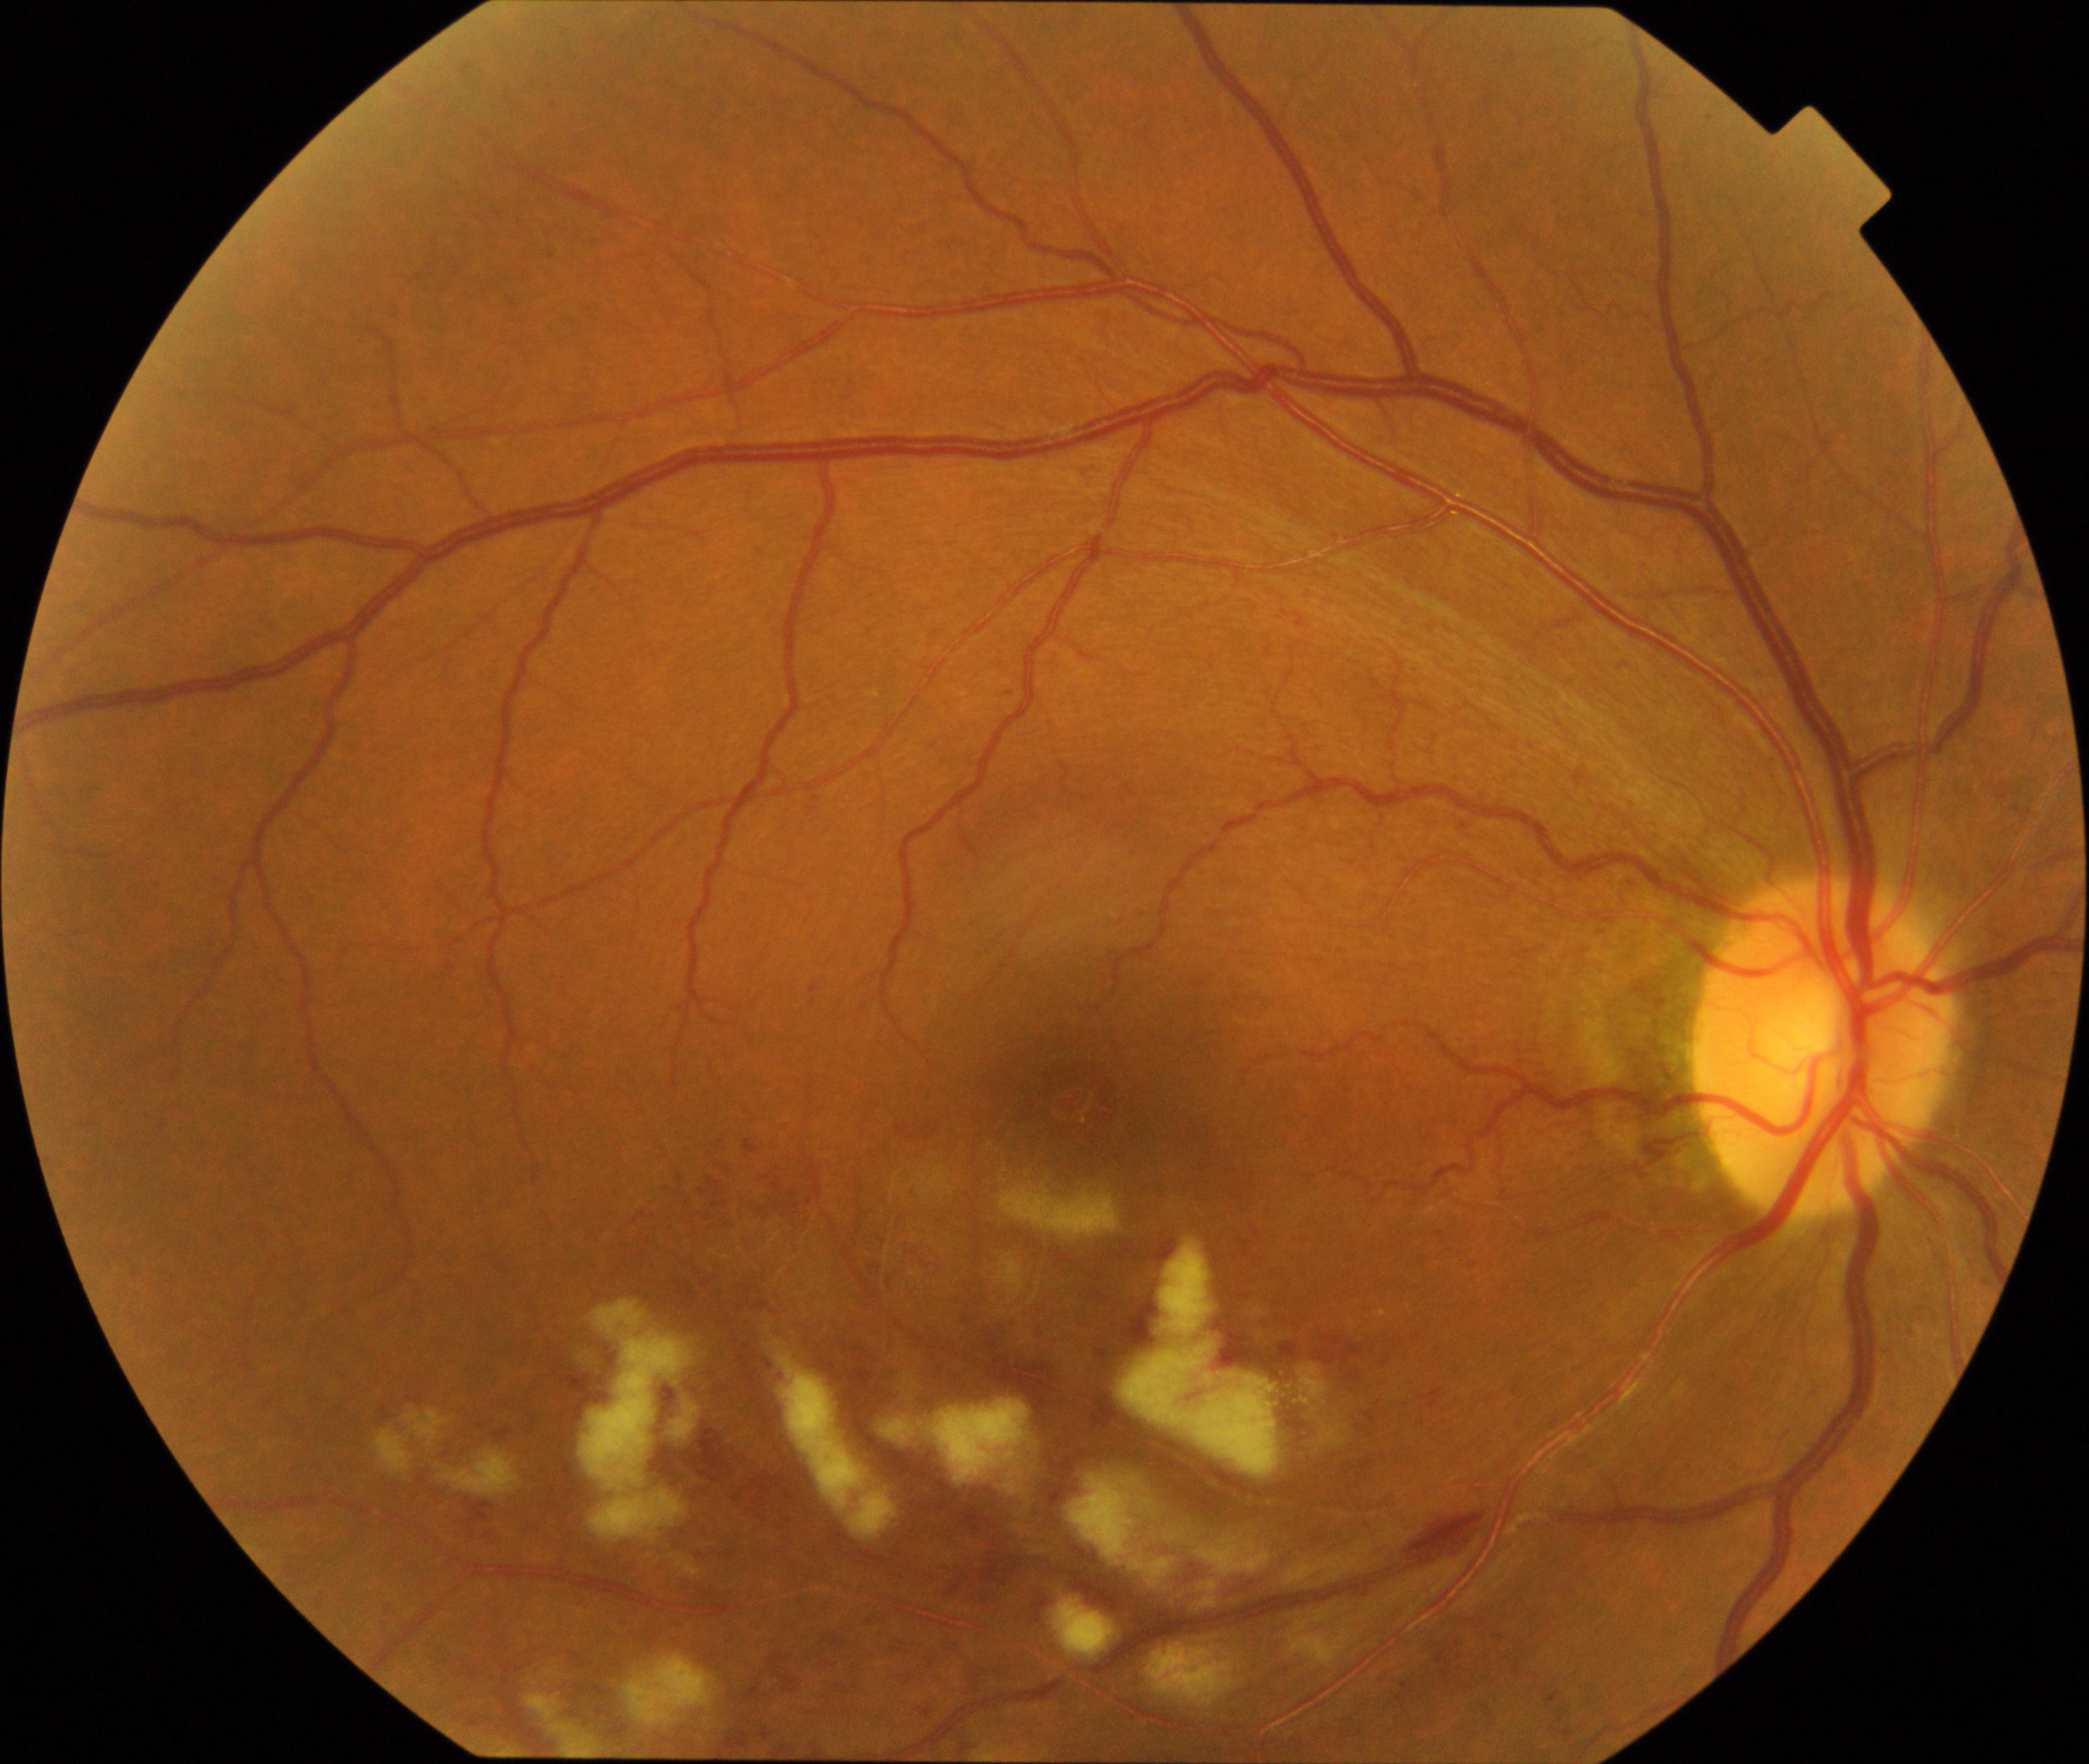 Findings: branch retinal vein occlusion (BRVO).